Fundus photo: 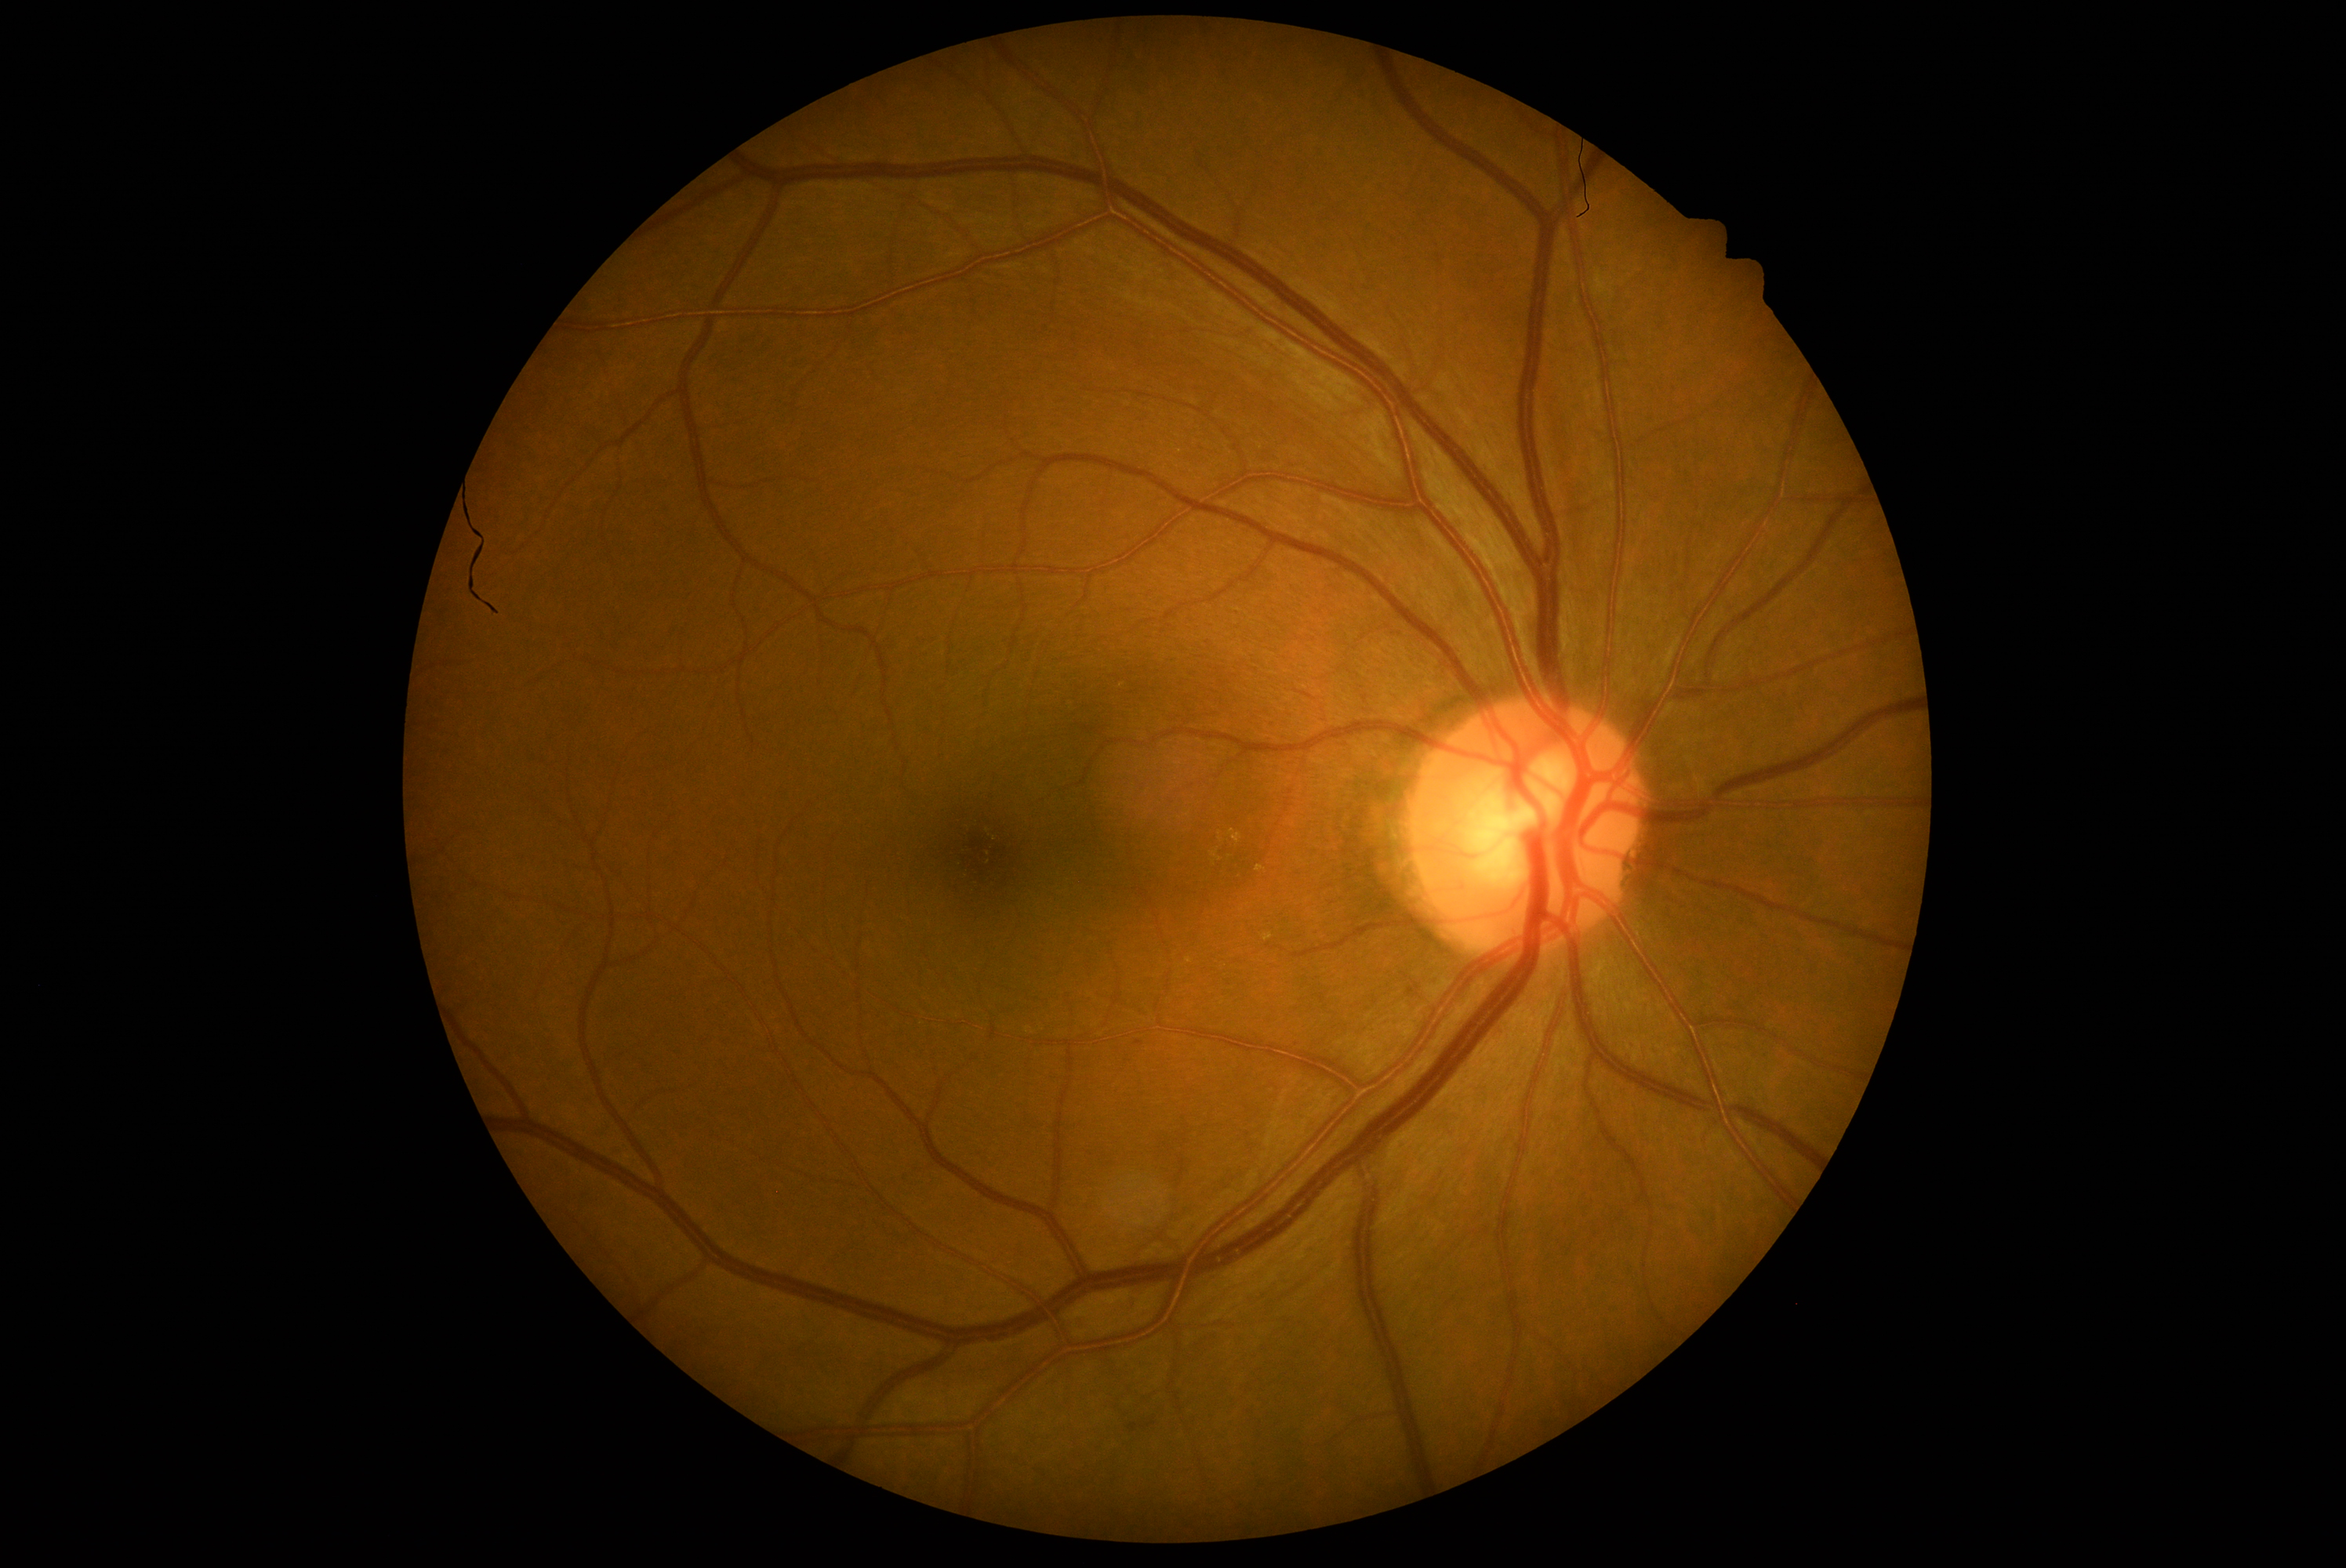
DR grade=1 (mild NPDR) — presence of microaneurysms only.